Camera: Kowa VX-10α:
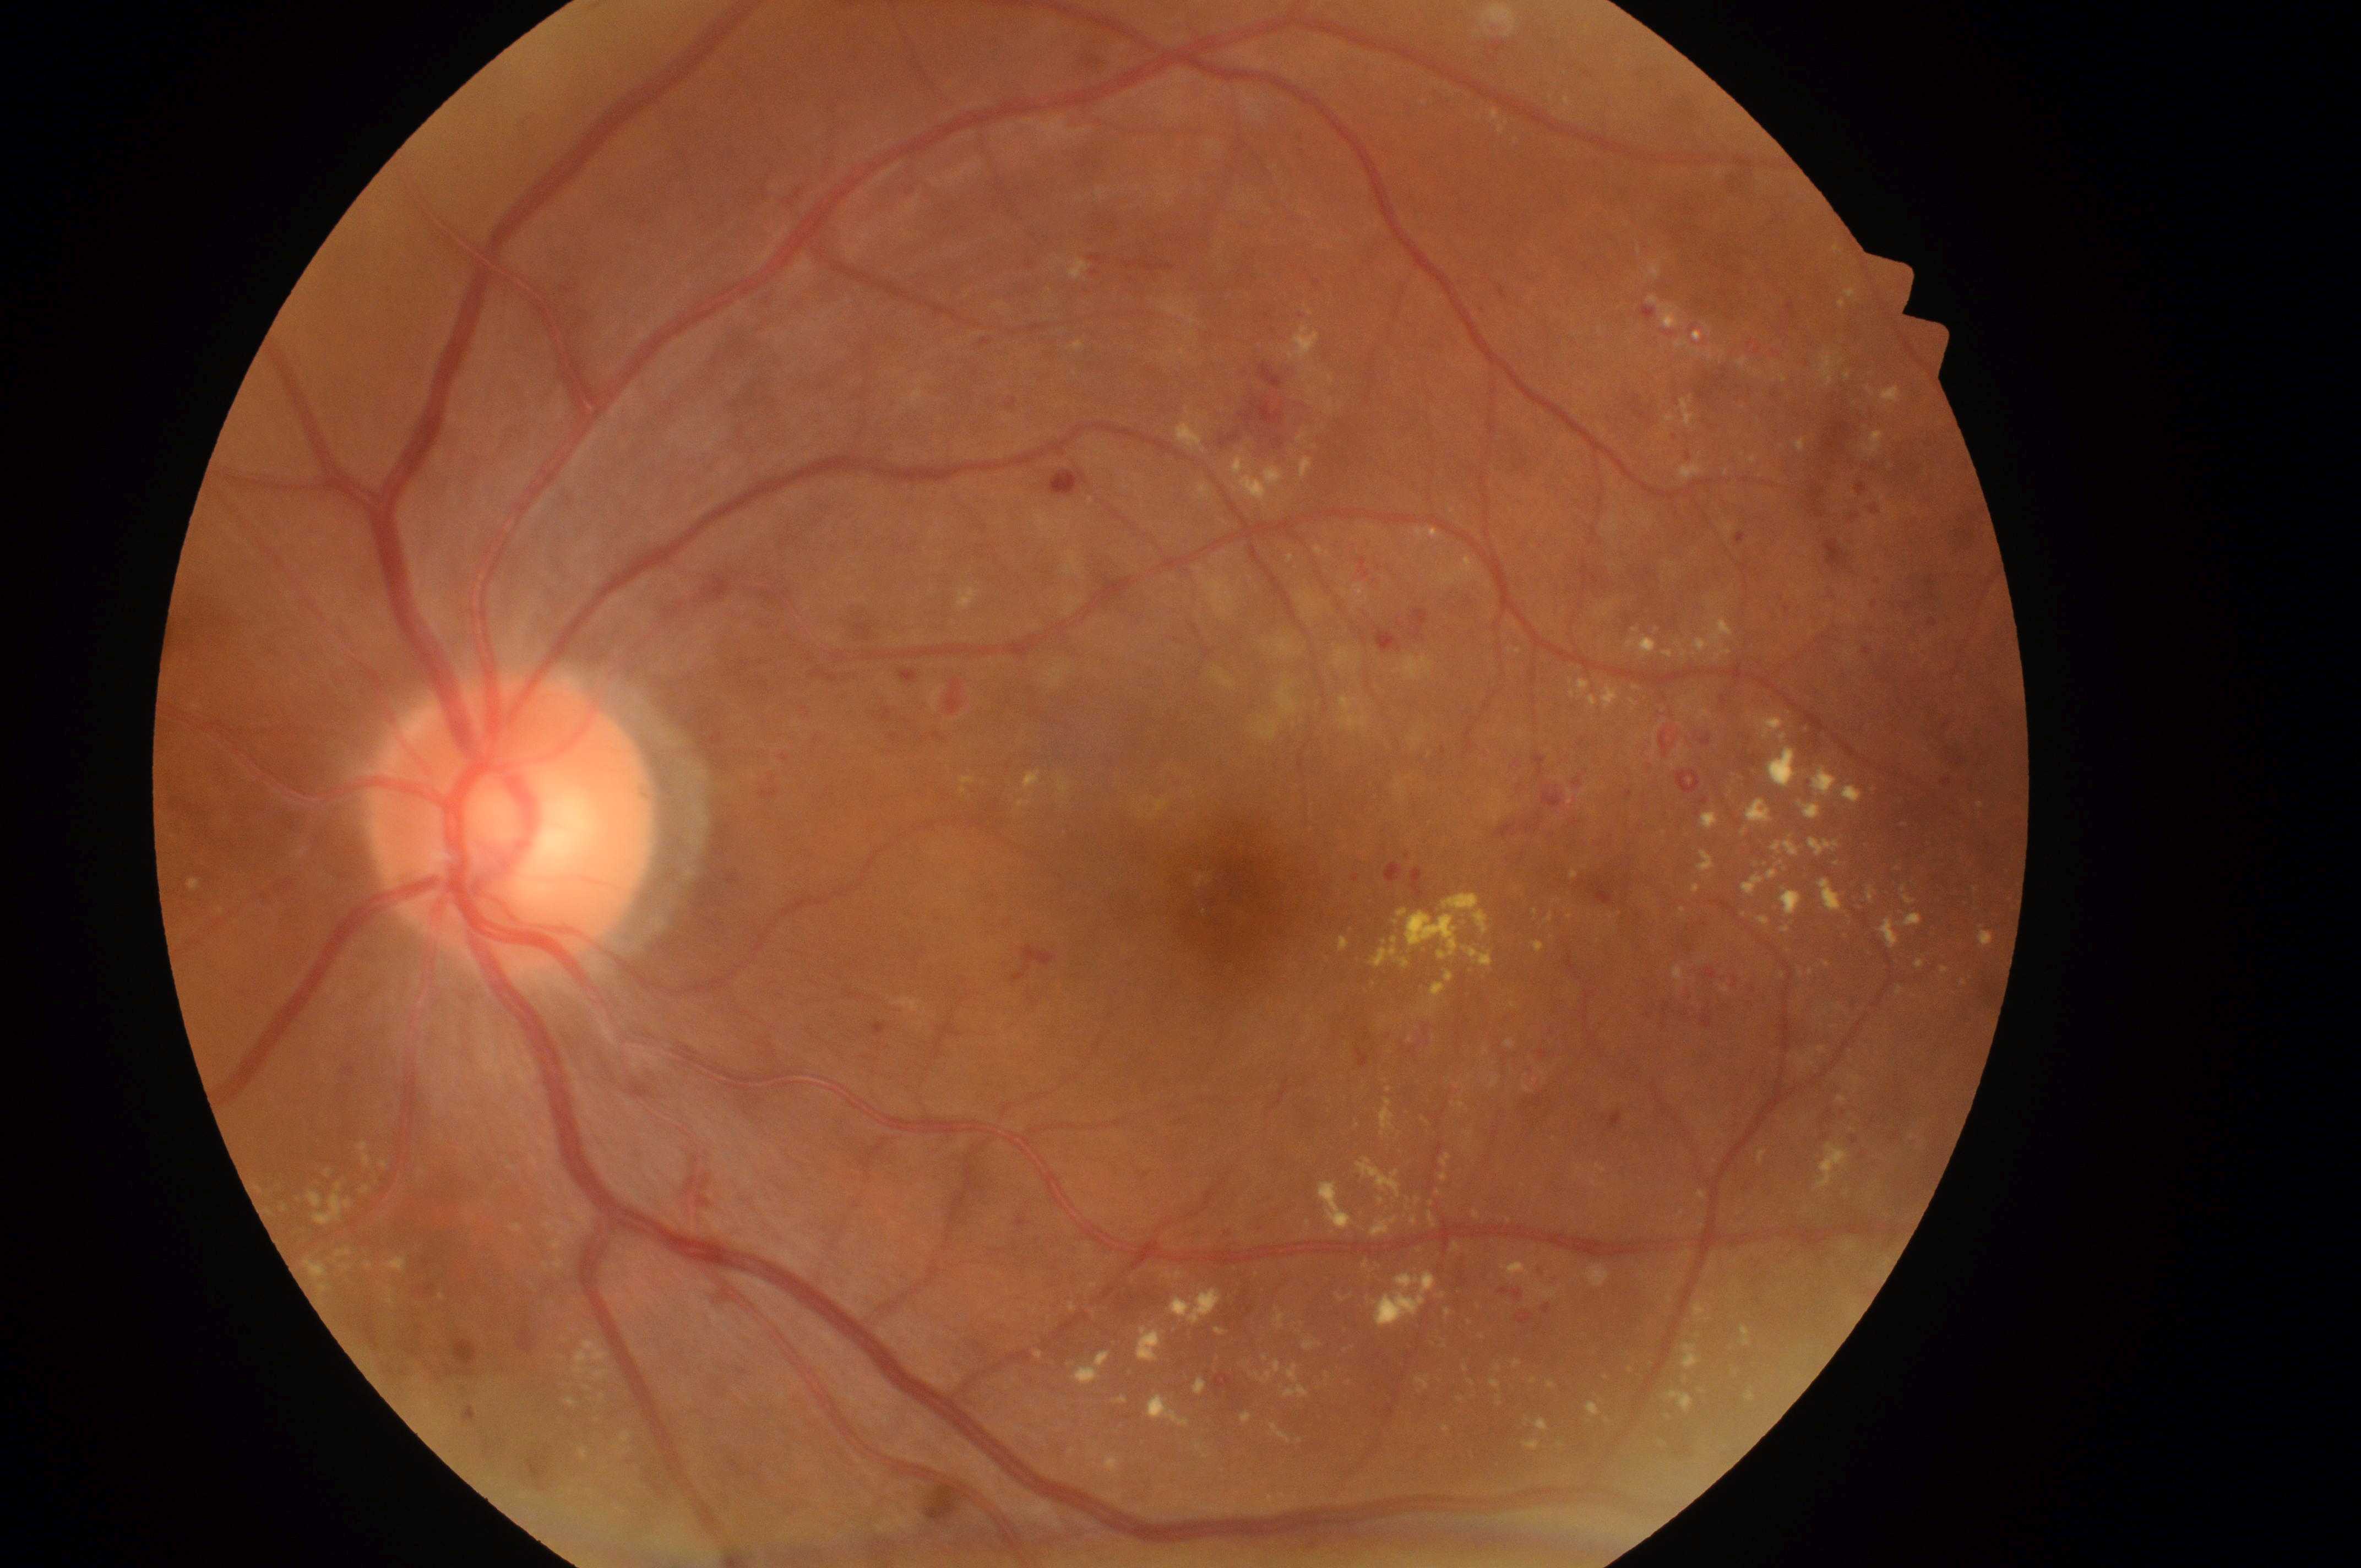

Disease class: non-proliferative diabetic retinopathy.
Disc center: [501, 837].
Fovea centralis: [1236, 901].
Imaged eye: left eye.
DME grade is 2/2.
DR severity is grade 3.